Fundus photo, nonmydriatic fundus photograph, NIDEK AFC-230.
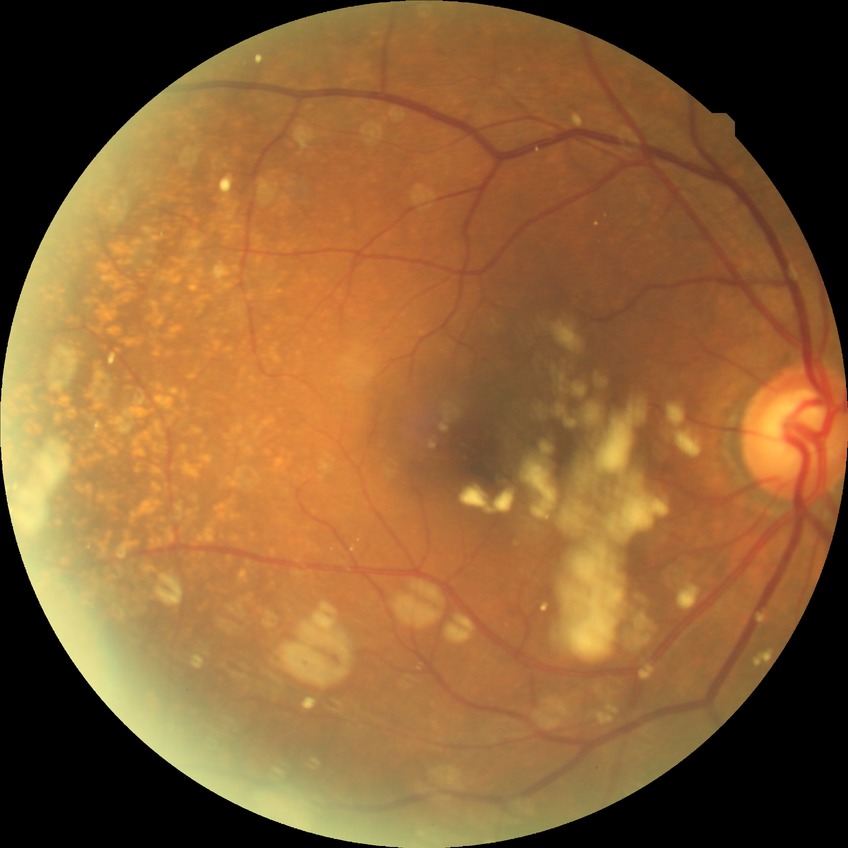

* diabetic retinopathy (DR) — no diabetic retinopathy (NDR)